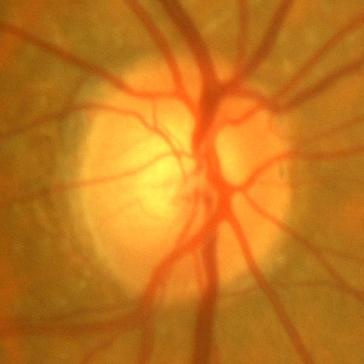
Diagnosis: no glaucomatous optic neuropathy.